Wide-field fundus image from infant ROP screening · captured with the Phoenix ICON (100° field of view).
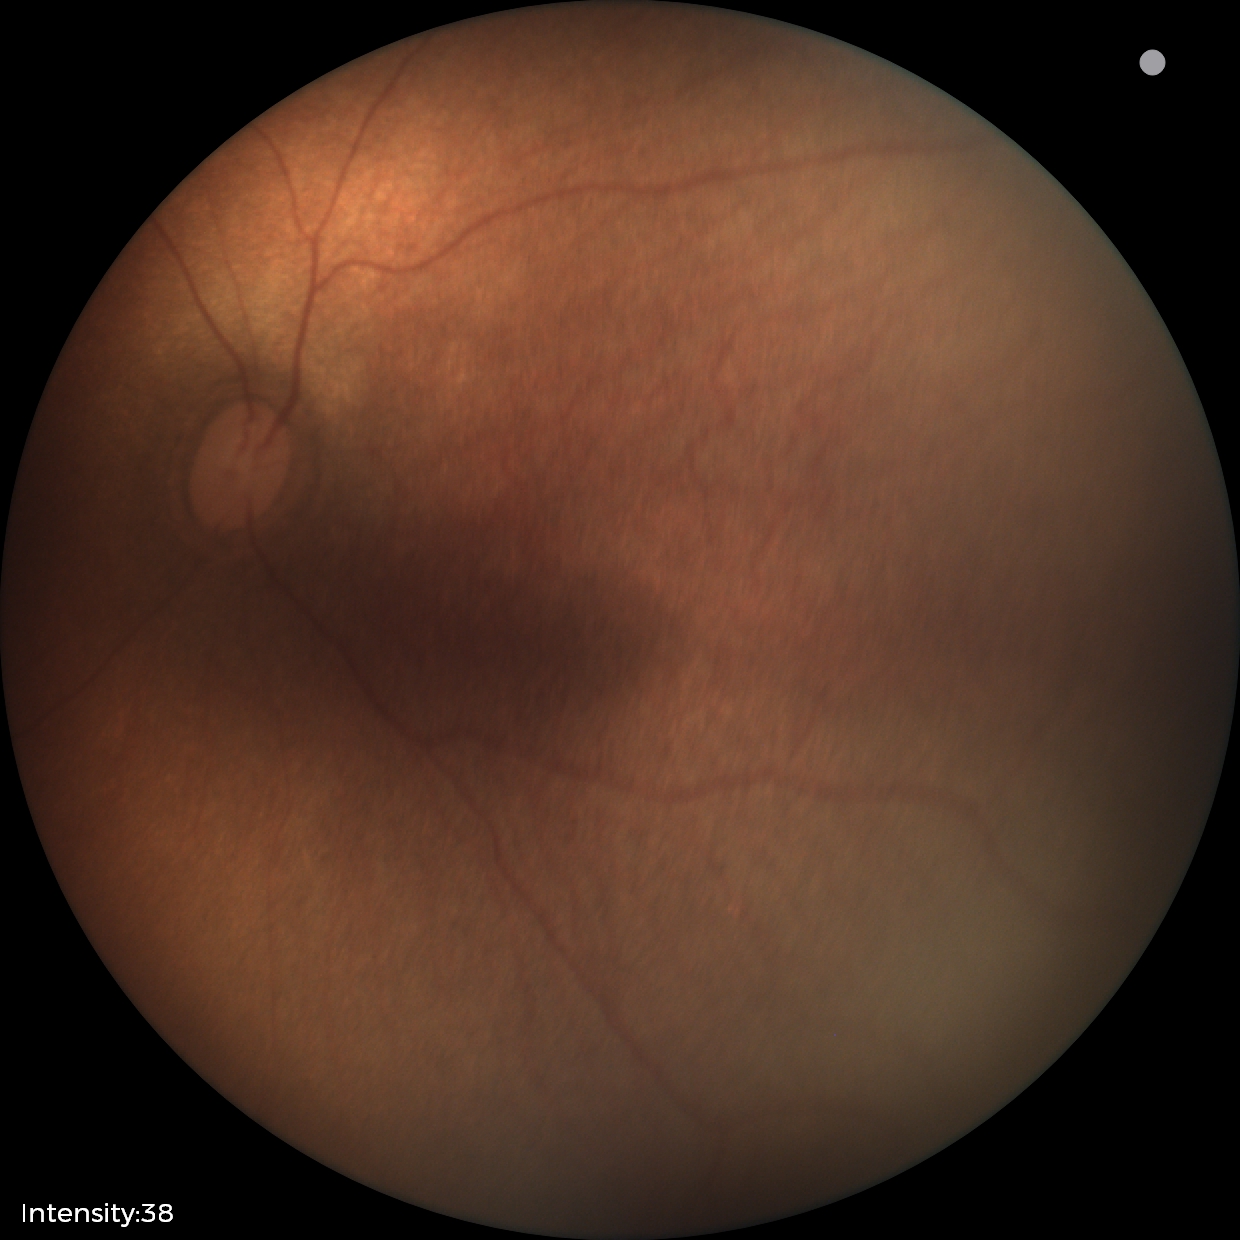

Screening examination with no abnormal retinal findings.